45 degree fundus photograph, modified Davis classification: 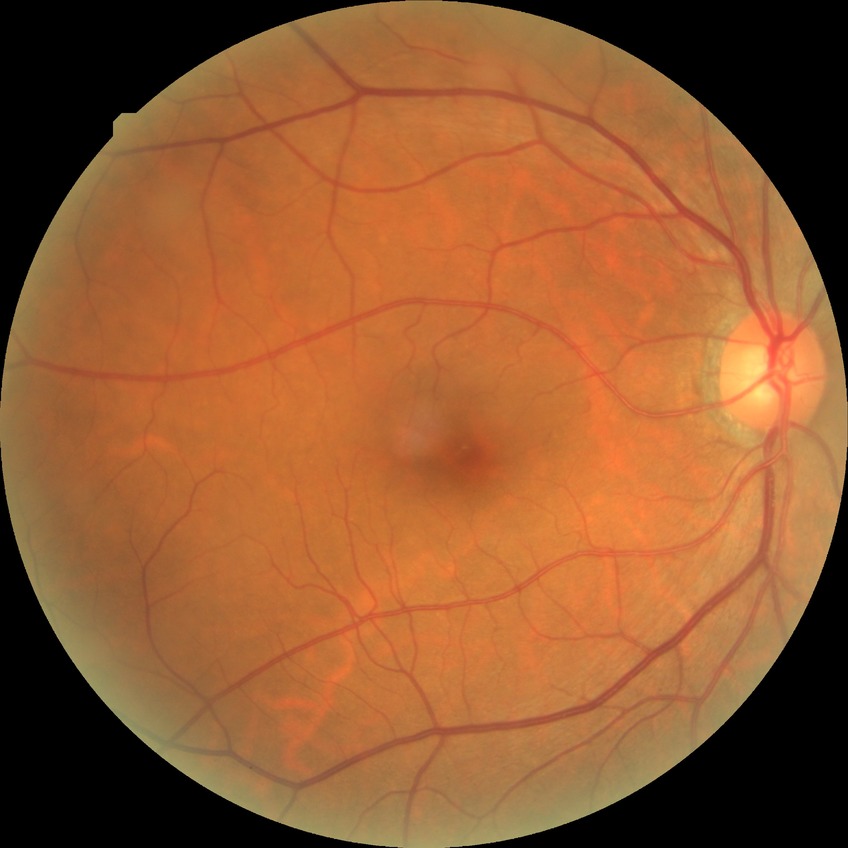
  davis_grade: no diabetic retinopathy